Posterior pole color fundus photograph, nonmydriatic, DR severity per modified Davis staging, 848 x 848 pixels:
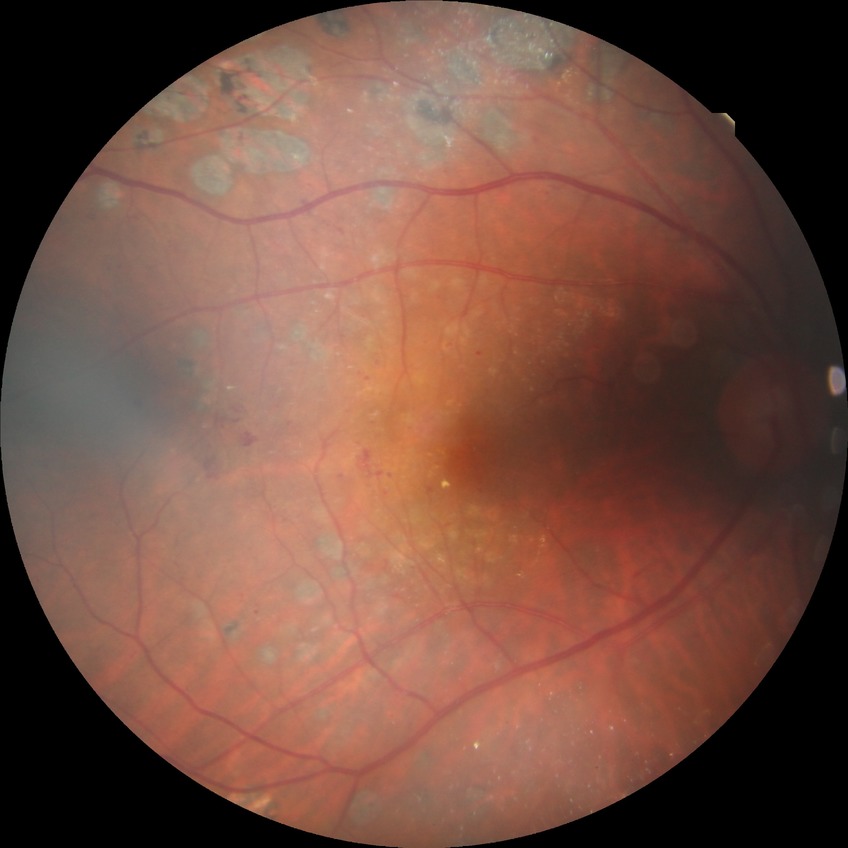
Diabetic retinopathy severity: proliferative diabetic retinopathy.